45-degree field of view, CFP
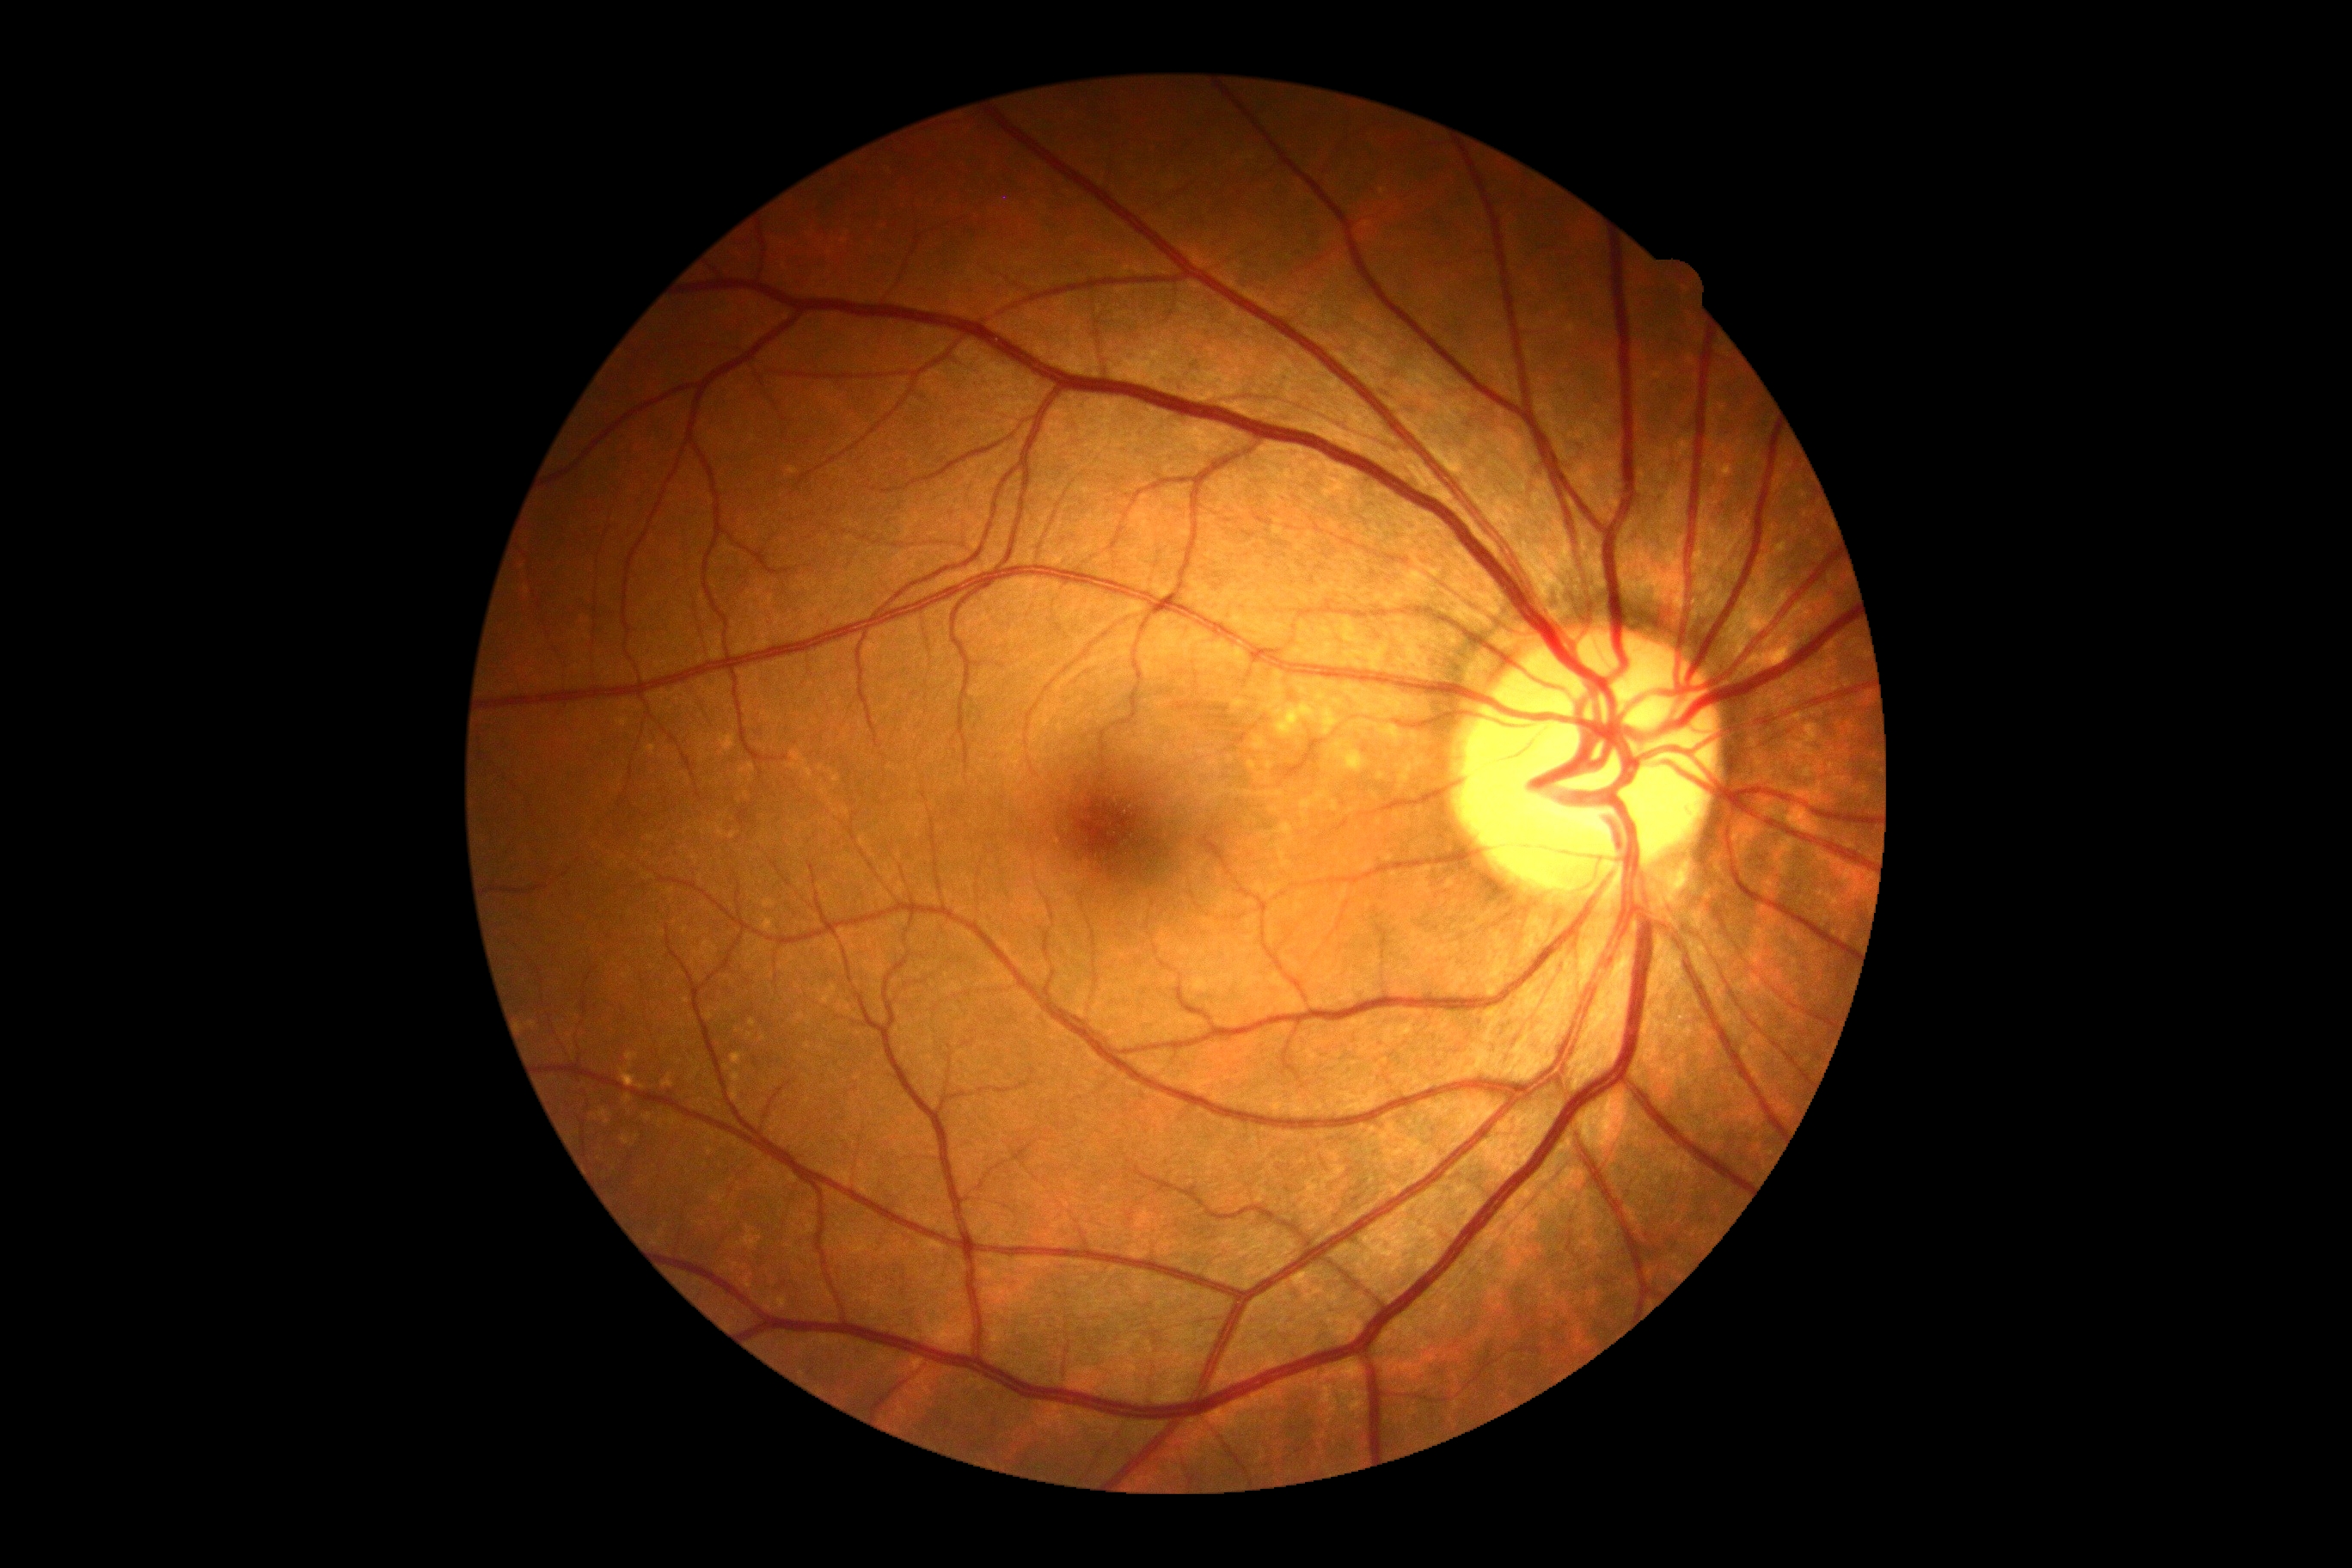

DR = no apparent retinopathy (grade 0).